1932x1932. 45° FOV — 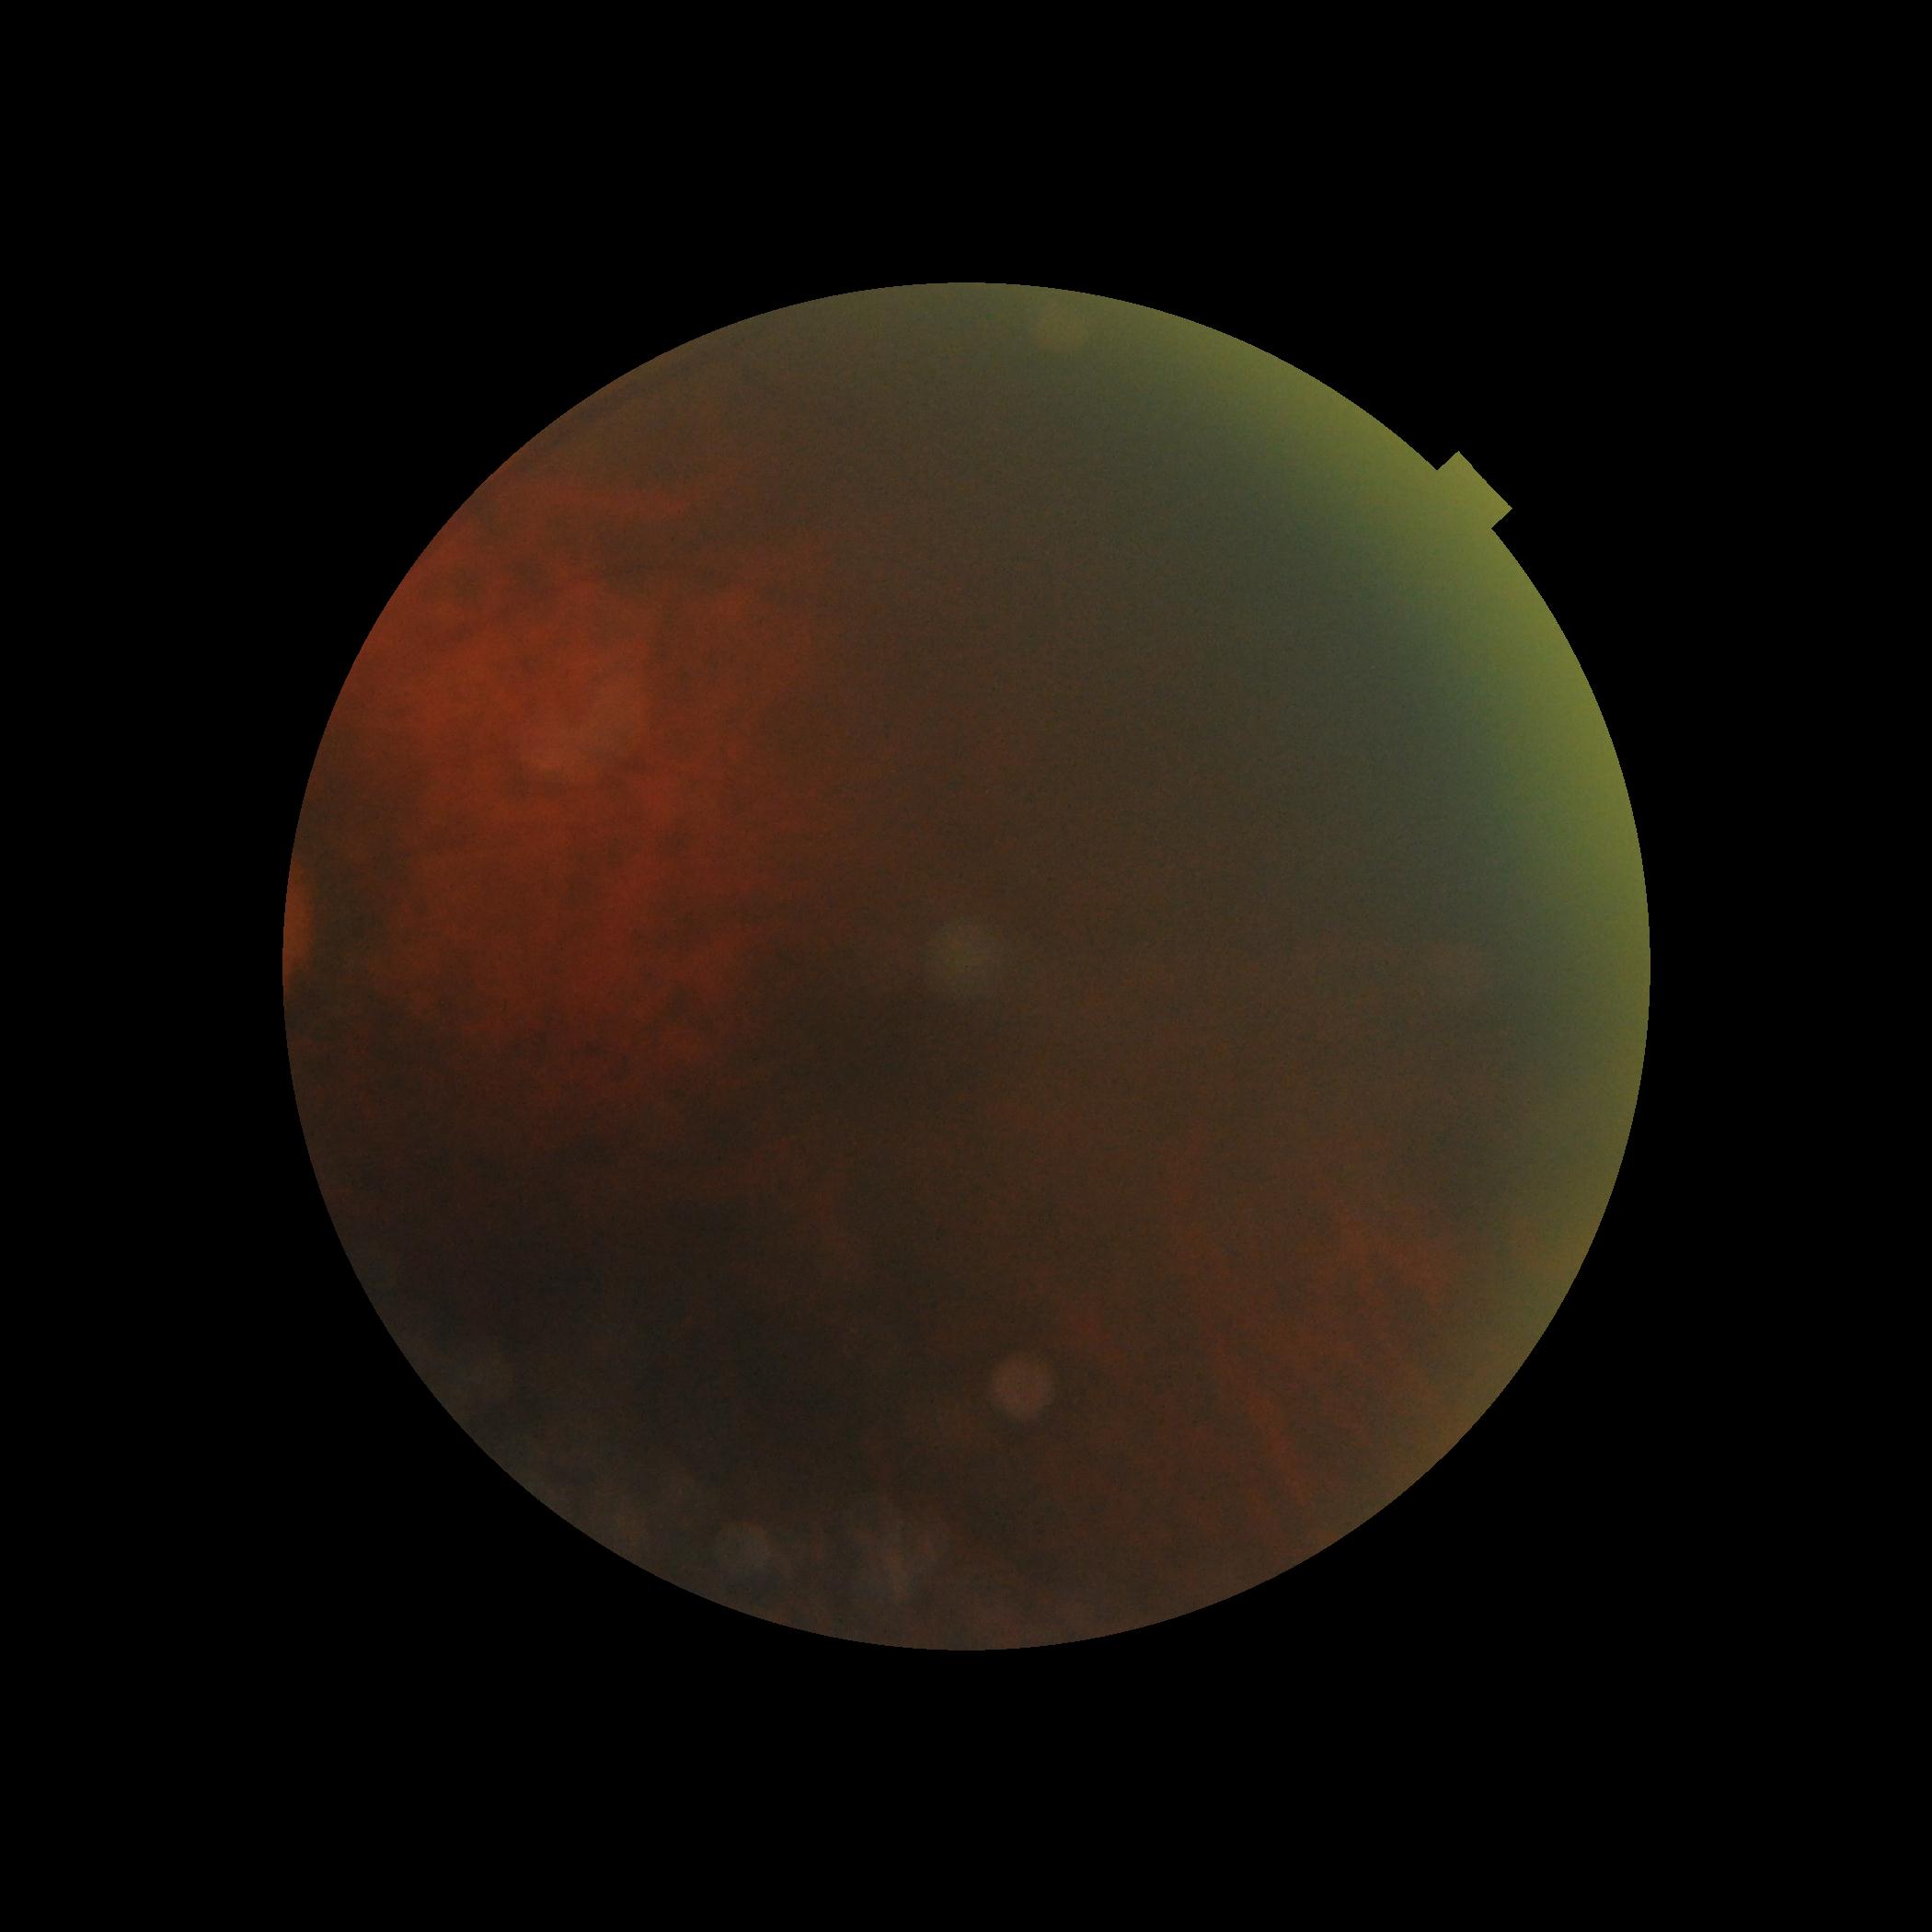
DR stage: ungradable.